Posterior pole color fundus photograph: 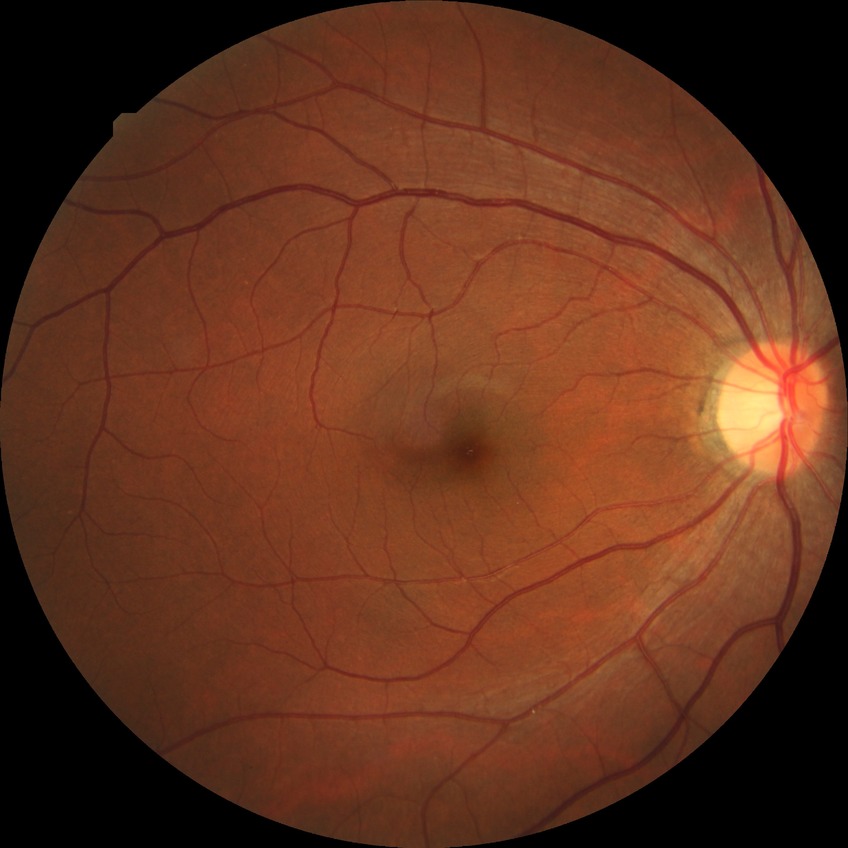 Diabetic retinopathy (DR): NDR (no diabetic retinopathy).